2352 by 1568 pixels, color fundus image, 45° field of view:
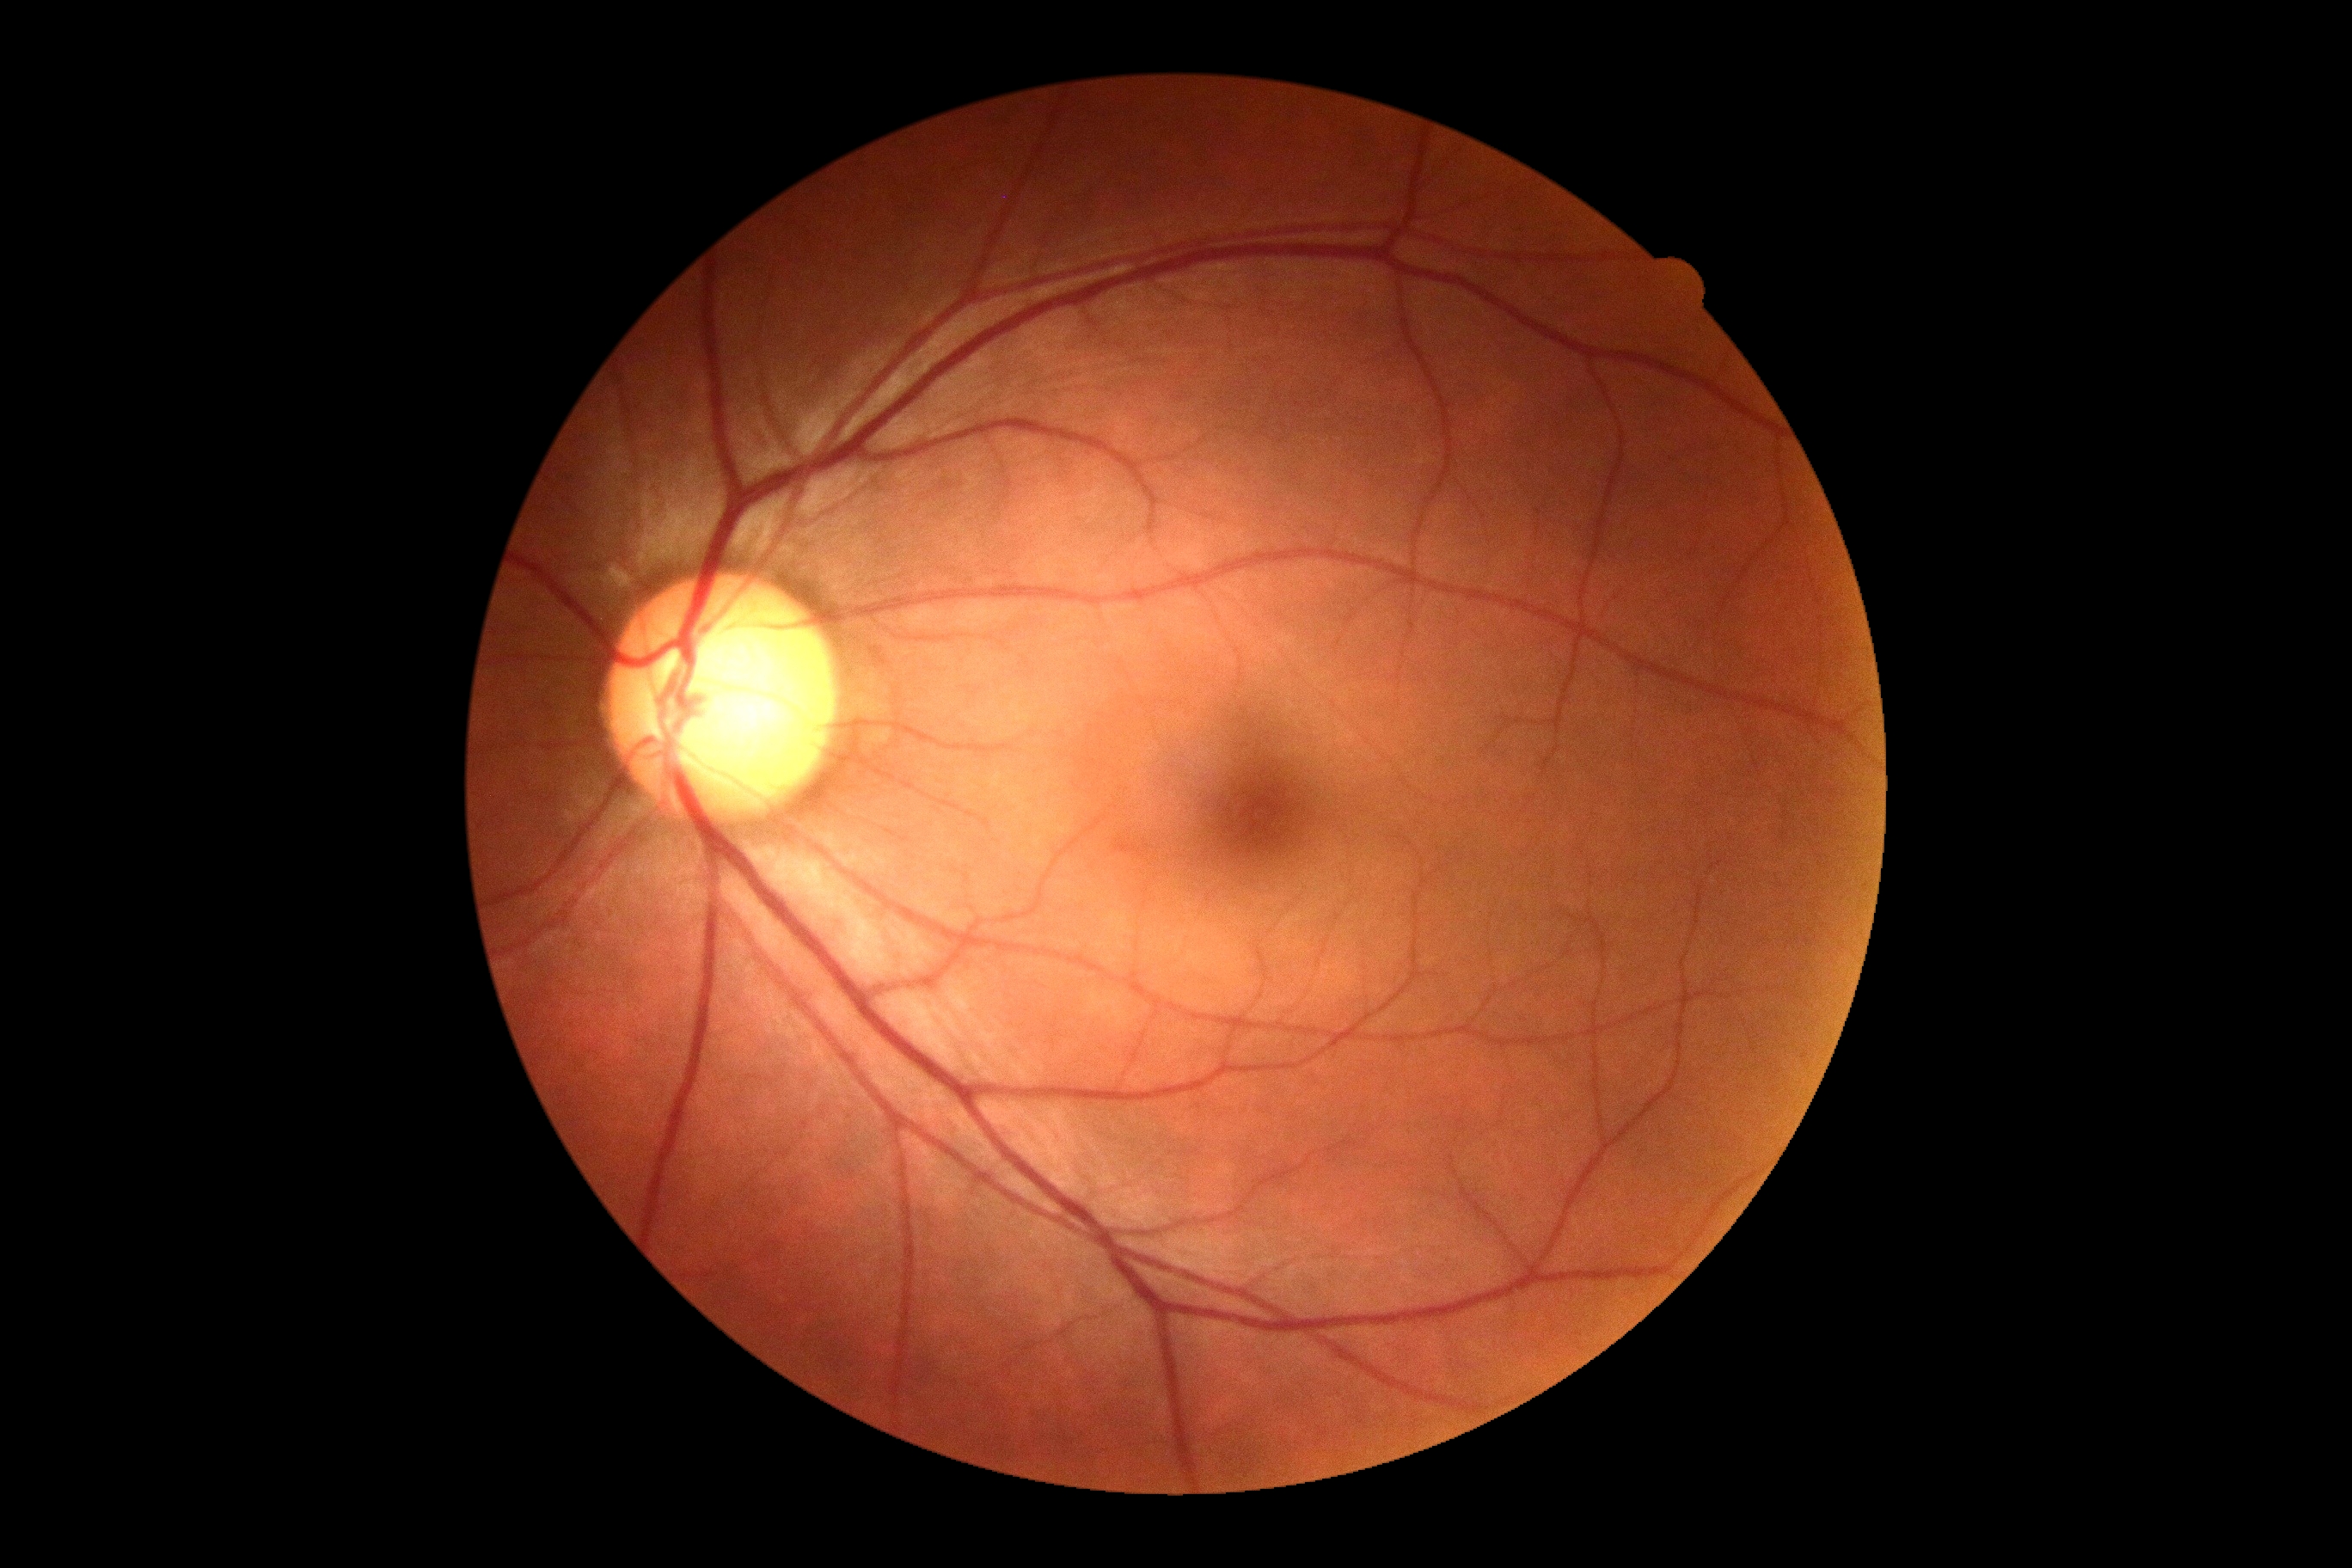
* diabetic retinopathy (DR): grade 0 (no apparent retinopathy)
* DR impression: no DR findings